45° field of view.
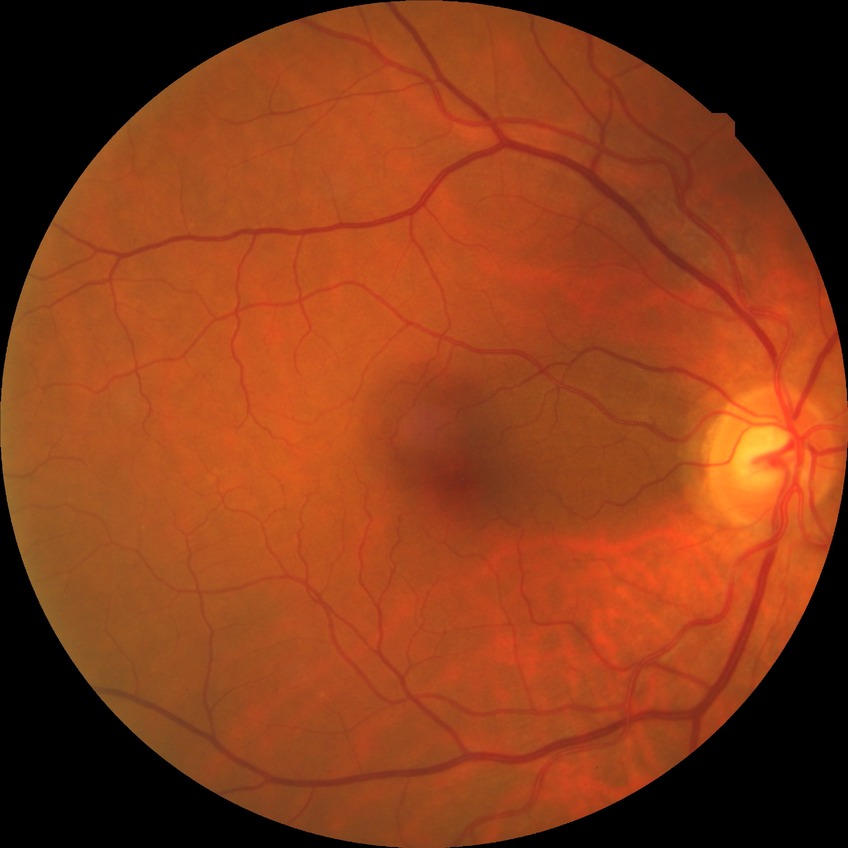 diabetic retinopathy (DR): no diabetic retinopathy (NDR).